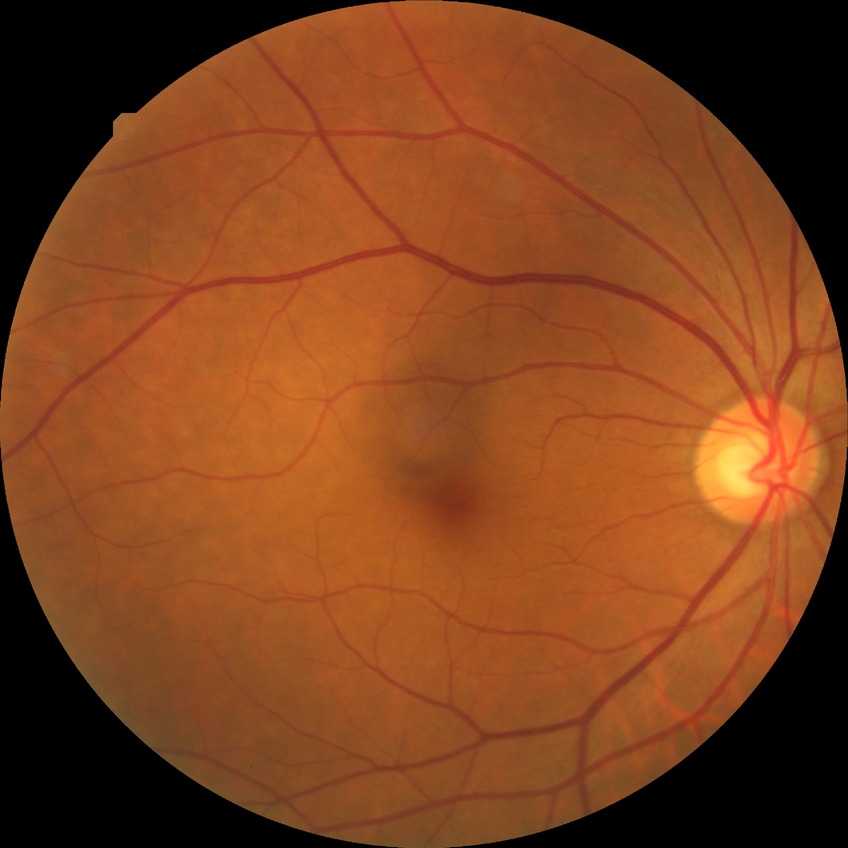

DR@NDR.